130° field of view (Clarity RetCam 3). Image size 640x480. RetCam wide-field infant fundus image.
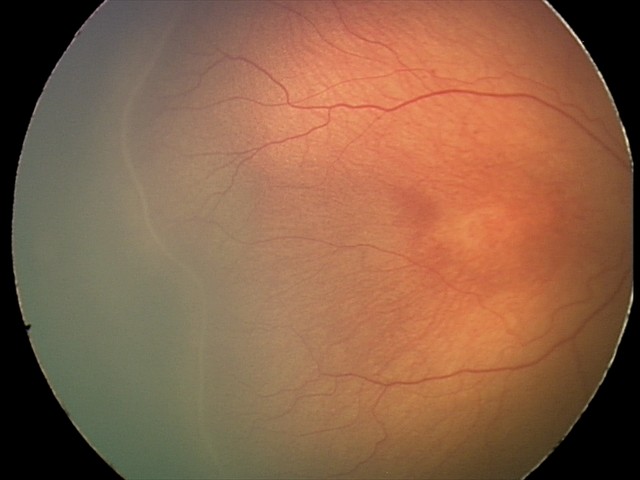
Plus disease absent.
From an examination with diagnosis of retinopathy of prematurity (ROP) stage 2.